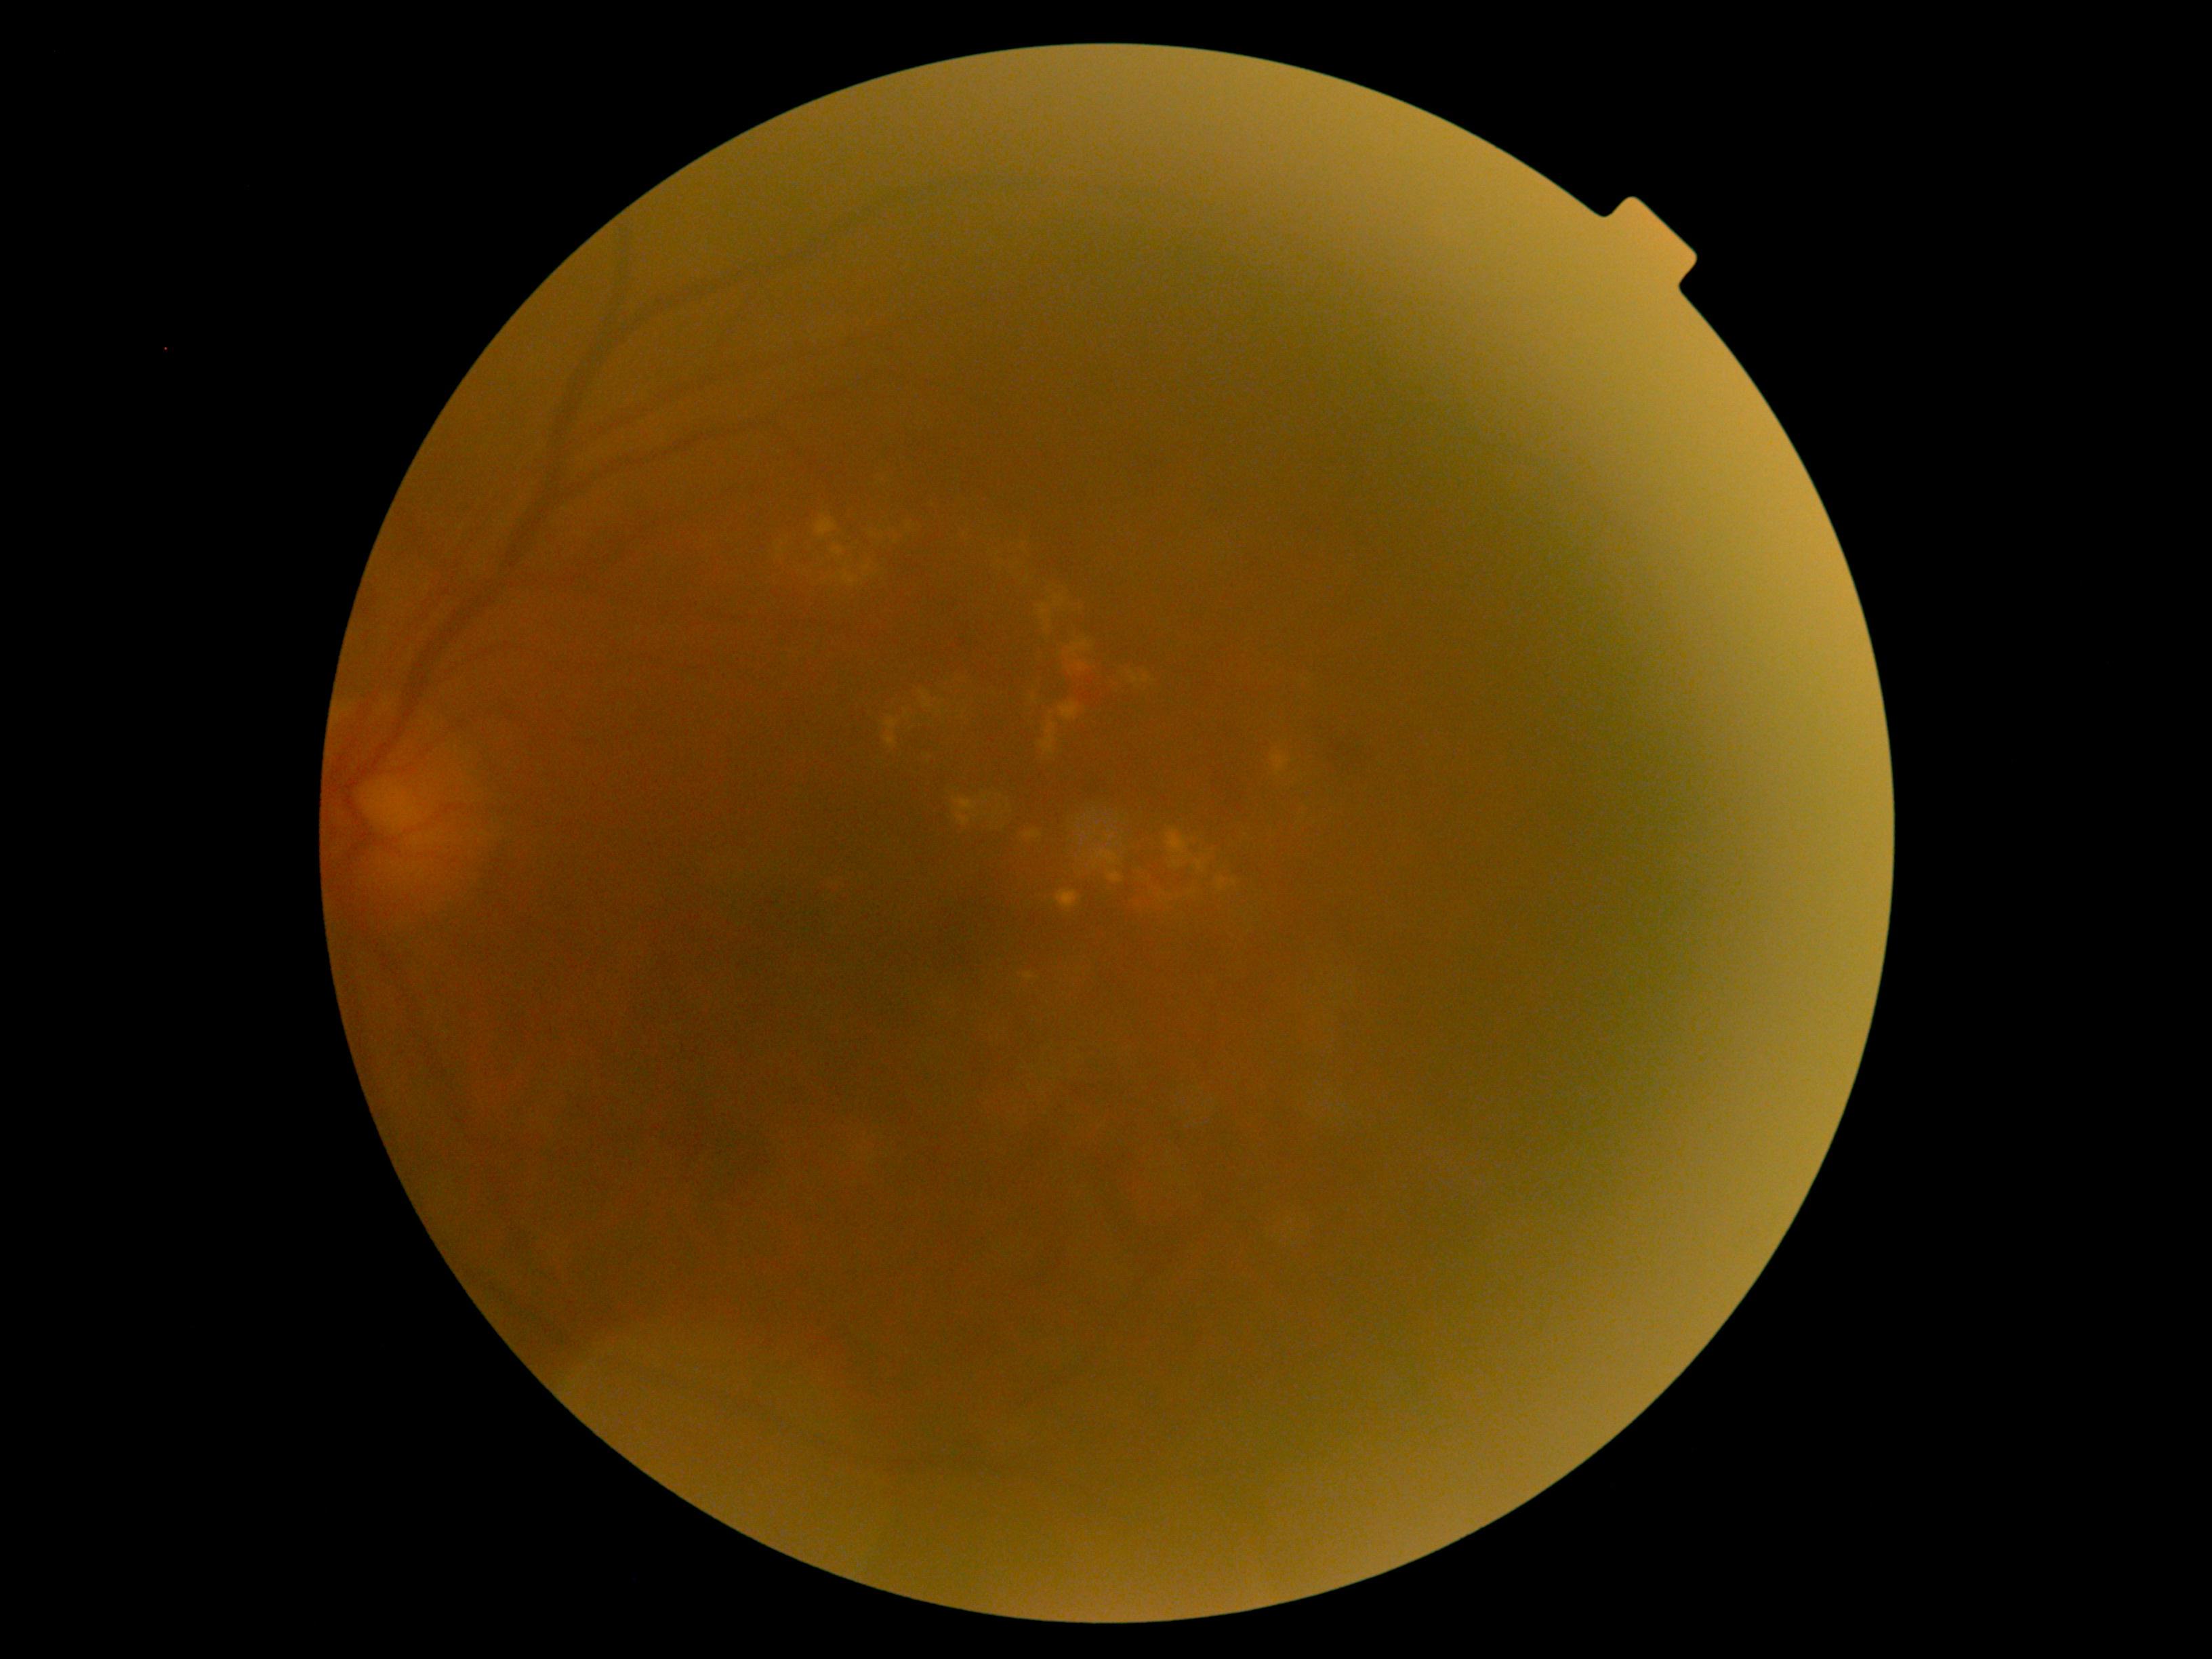

Retinopathy: grade 2.